45° field of view; image size 2352x1568; color fundus image:
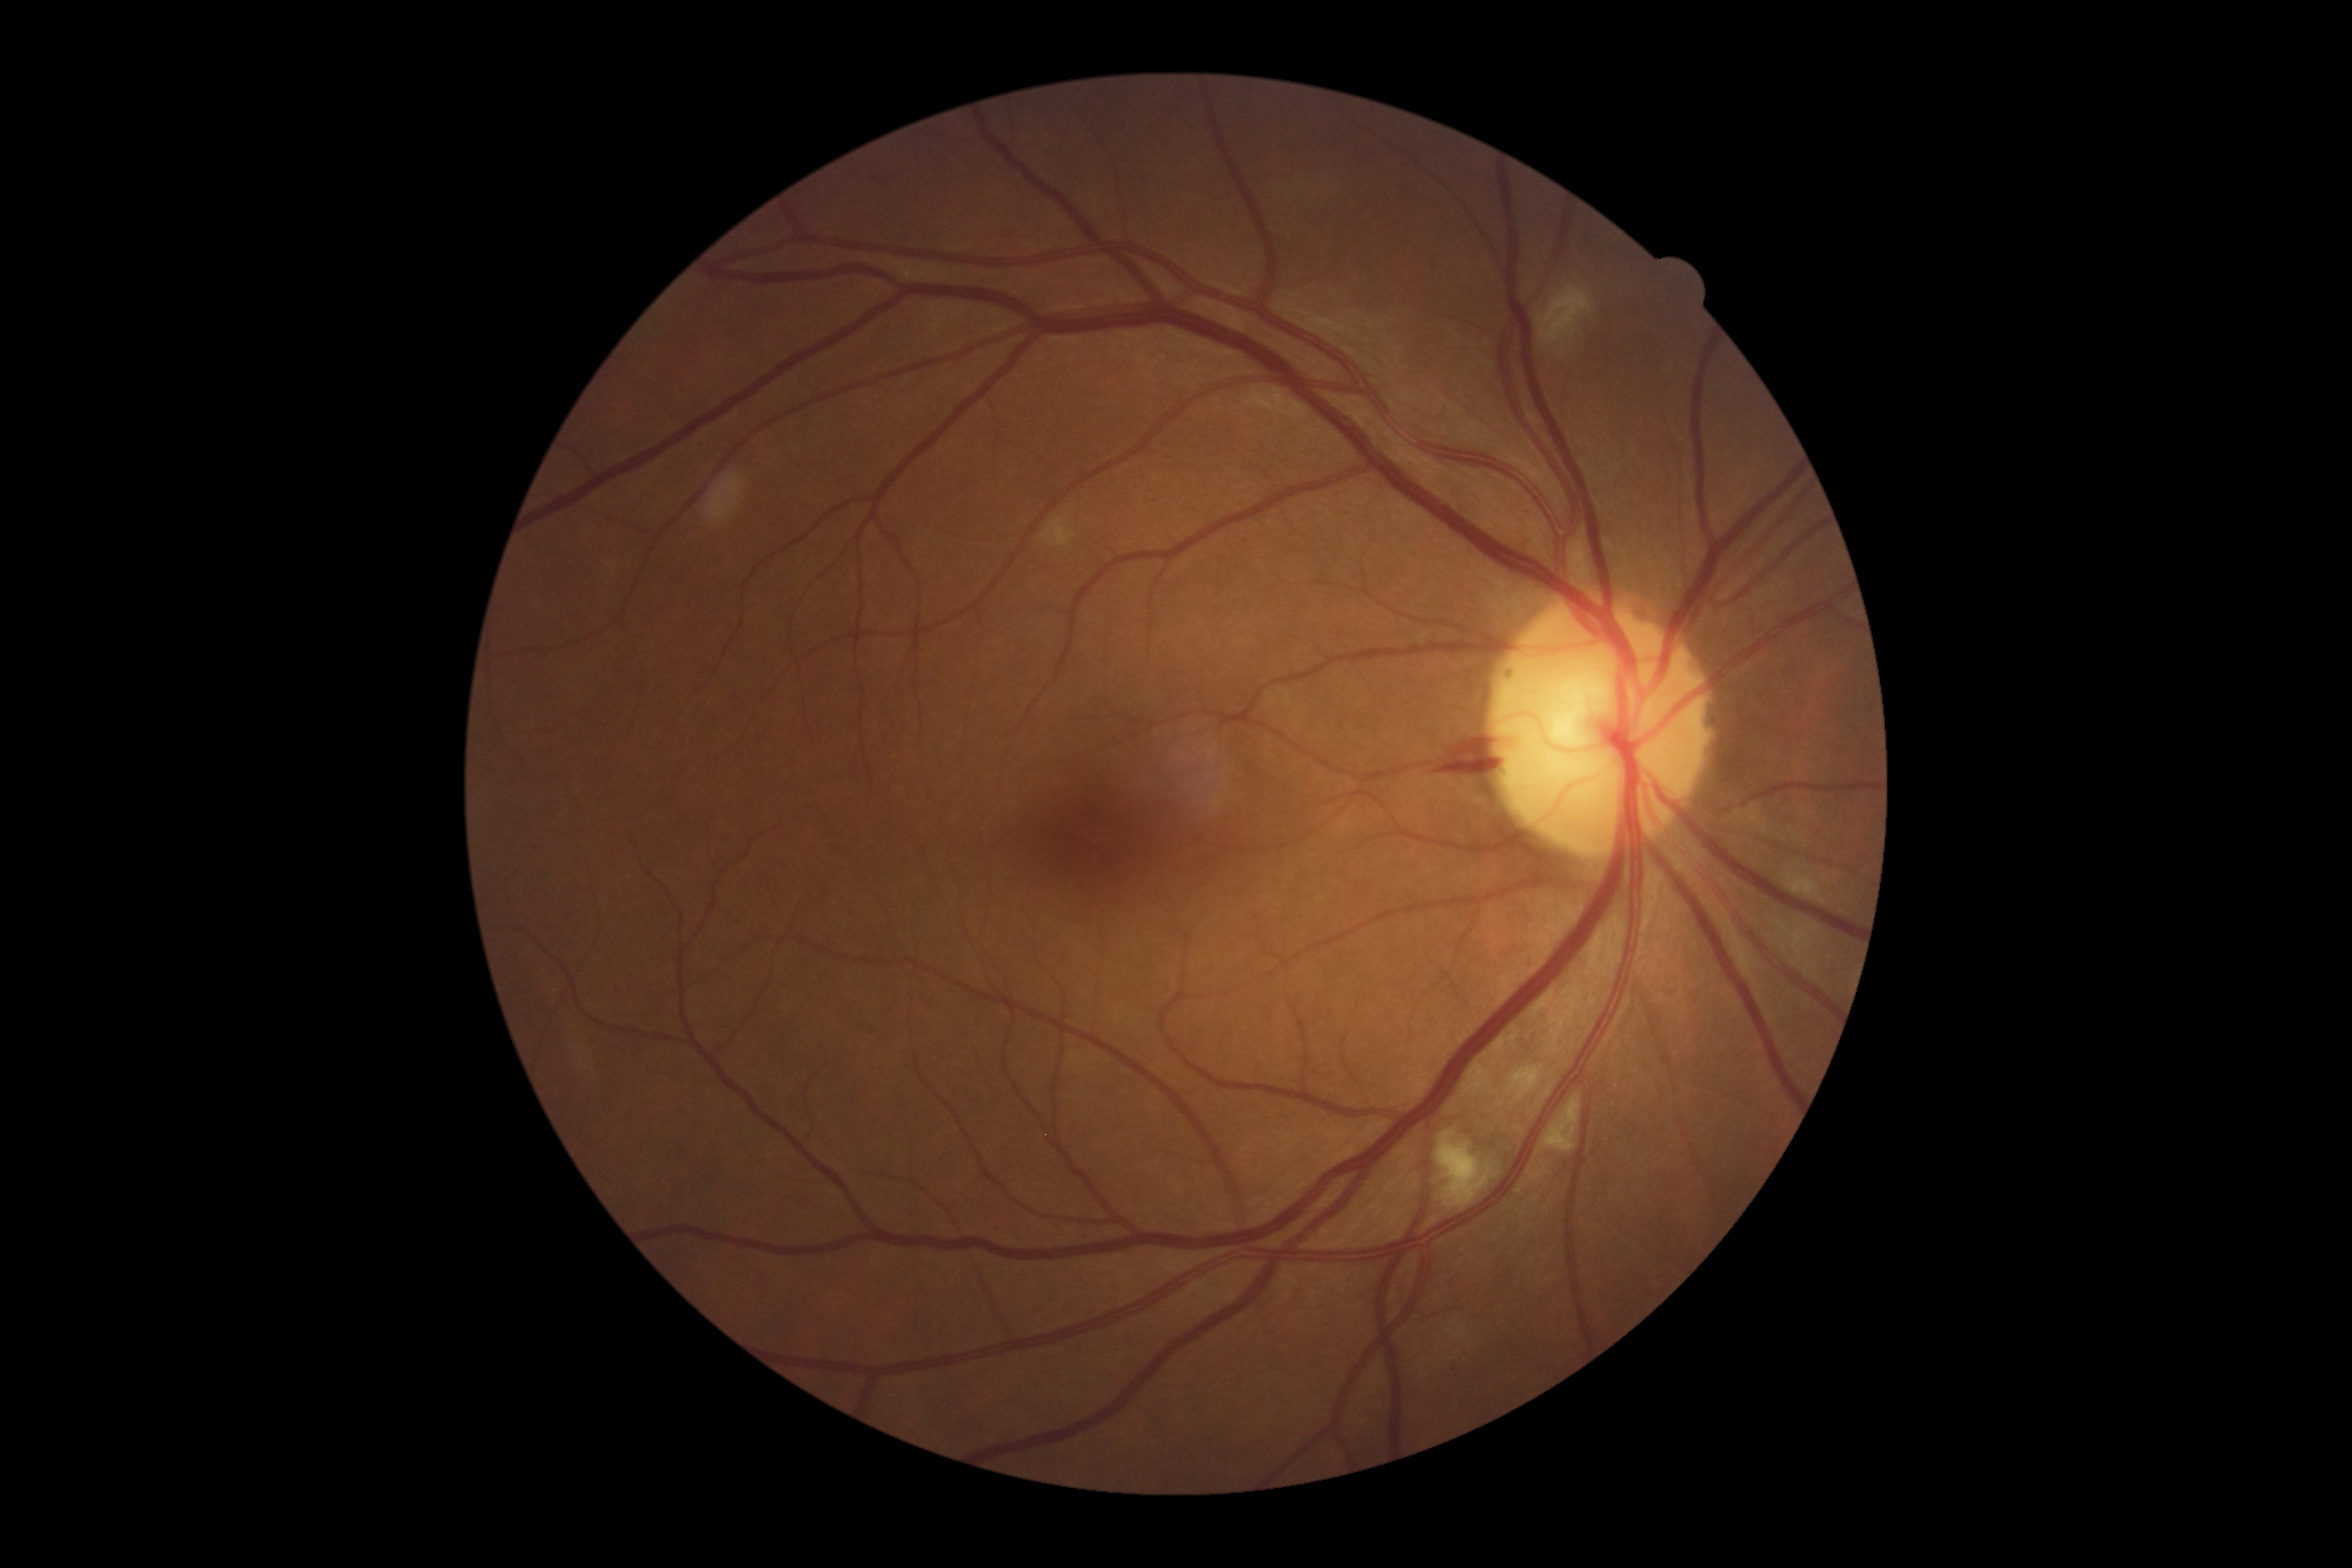
DR stage is grade 2.